CFP · 1624 by 1232 pixels · FOV: 45 degrees.
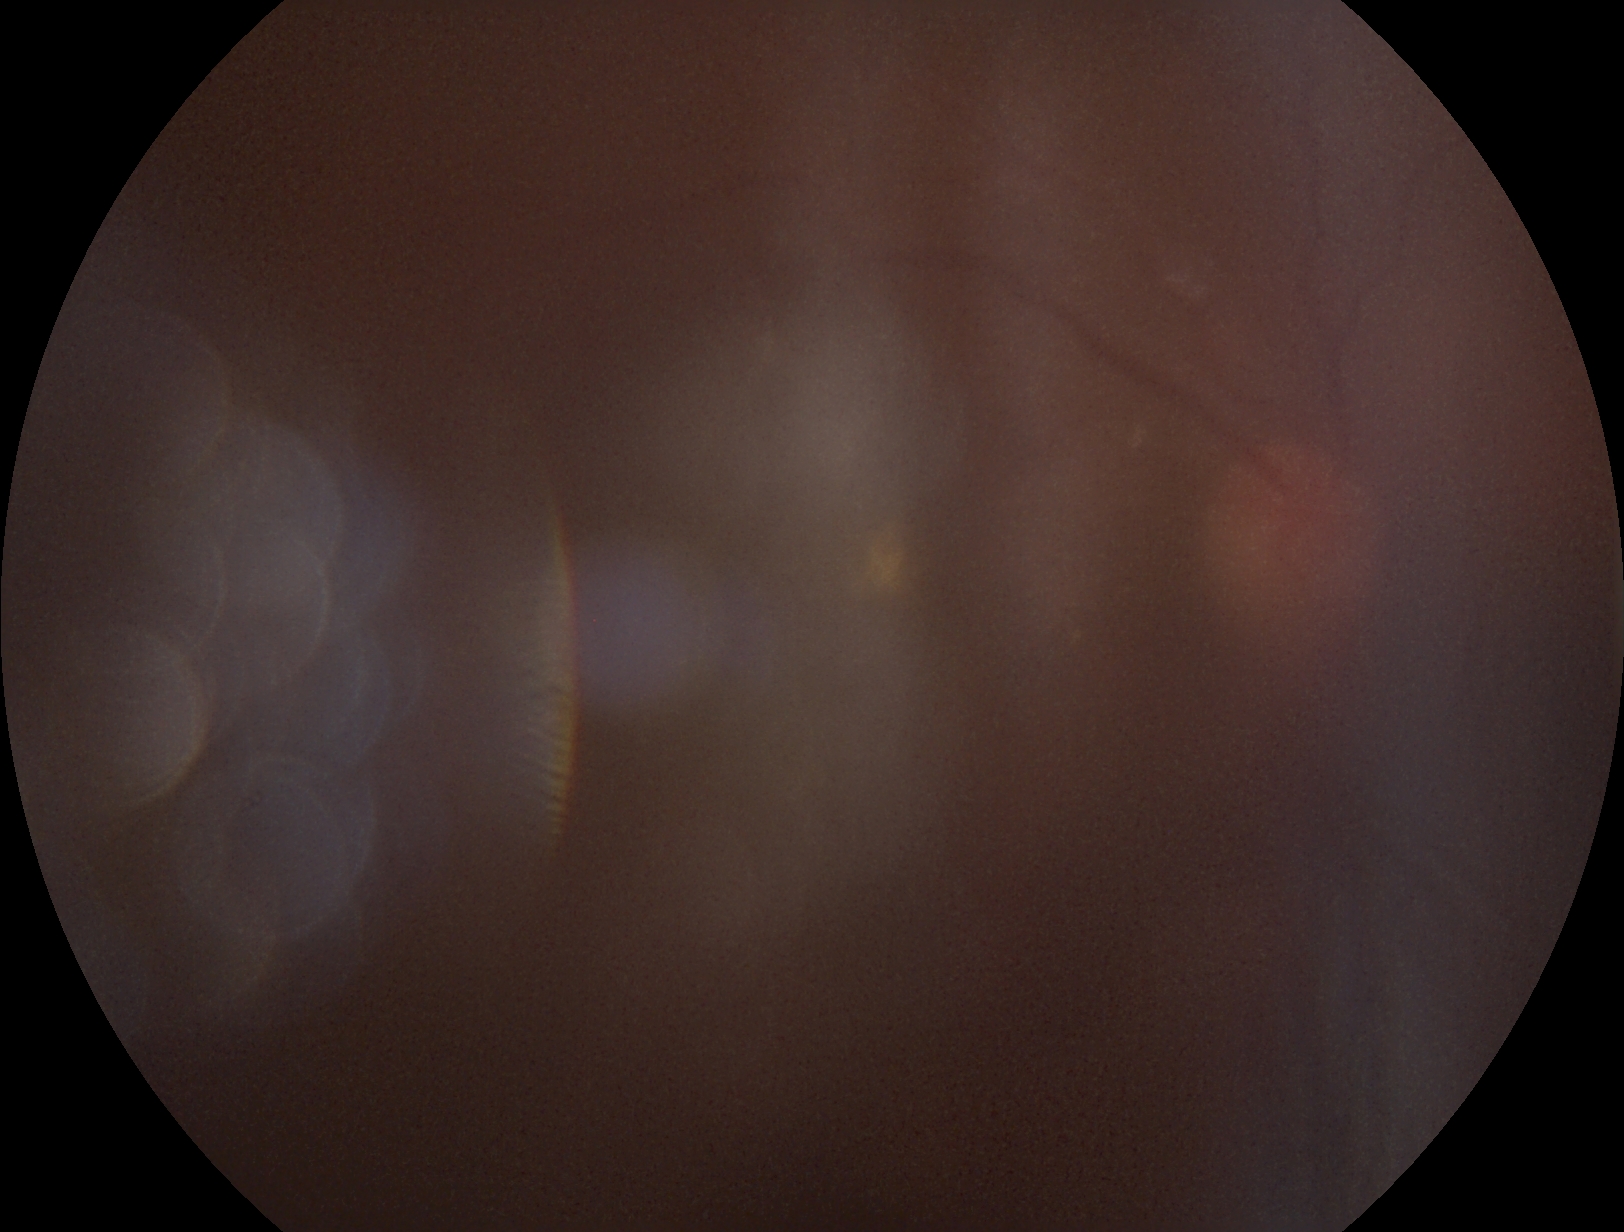

DR is ungradable due to poor image quality.